Camera: Clarity RetCam 3 (130° FOV). Infant wide-field fundus photograph:
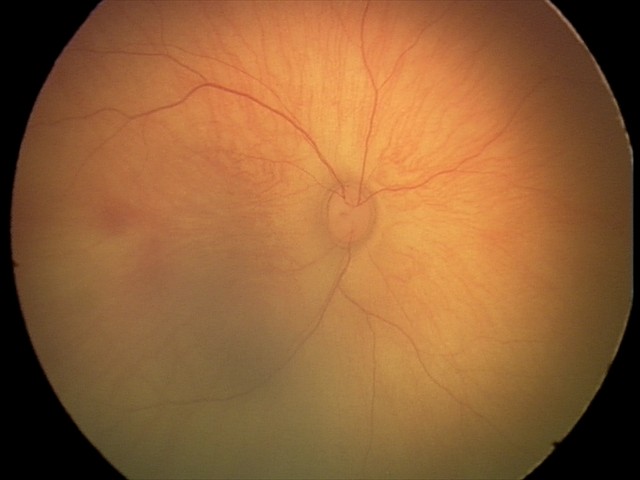 Series diagnosed as retinal hemorrhages.